Modified Davis classification; CFP:
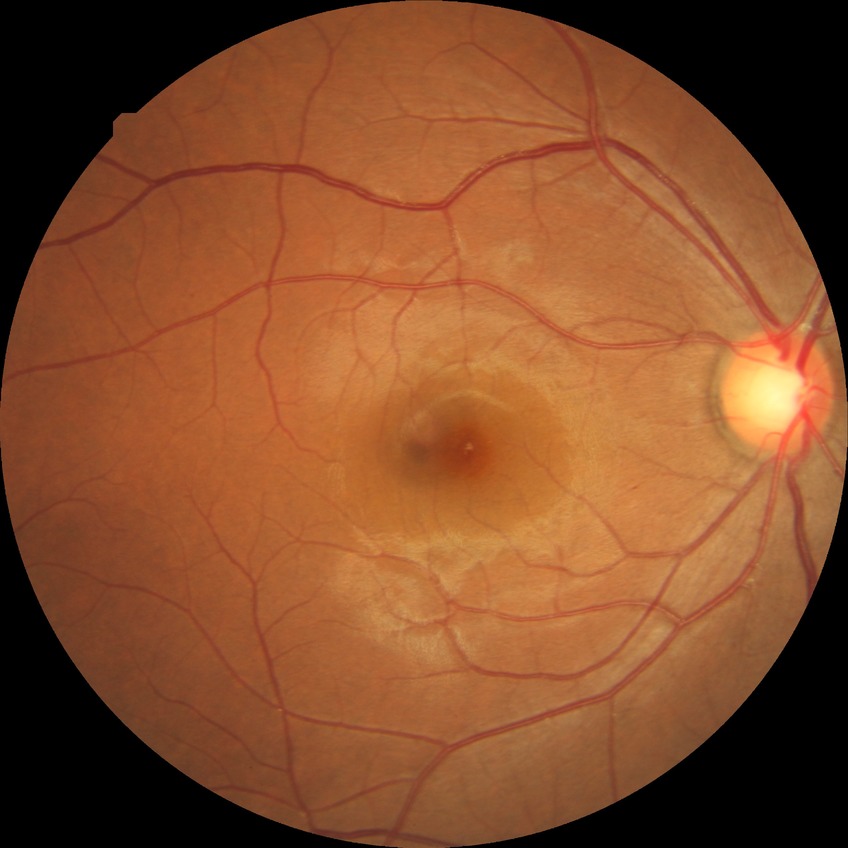
Davis grading: simple diabetic retinopathy.